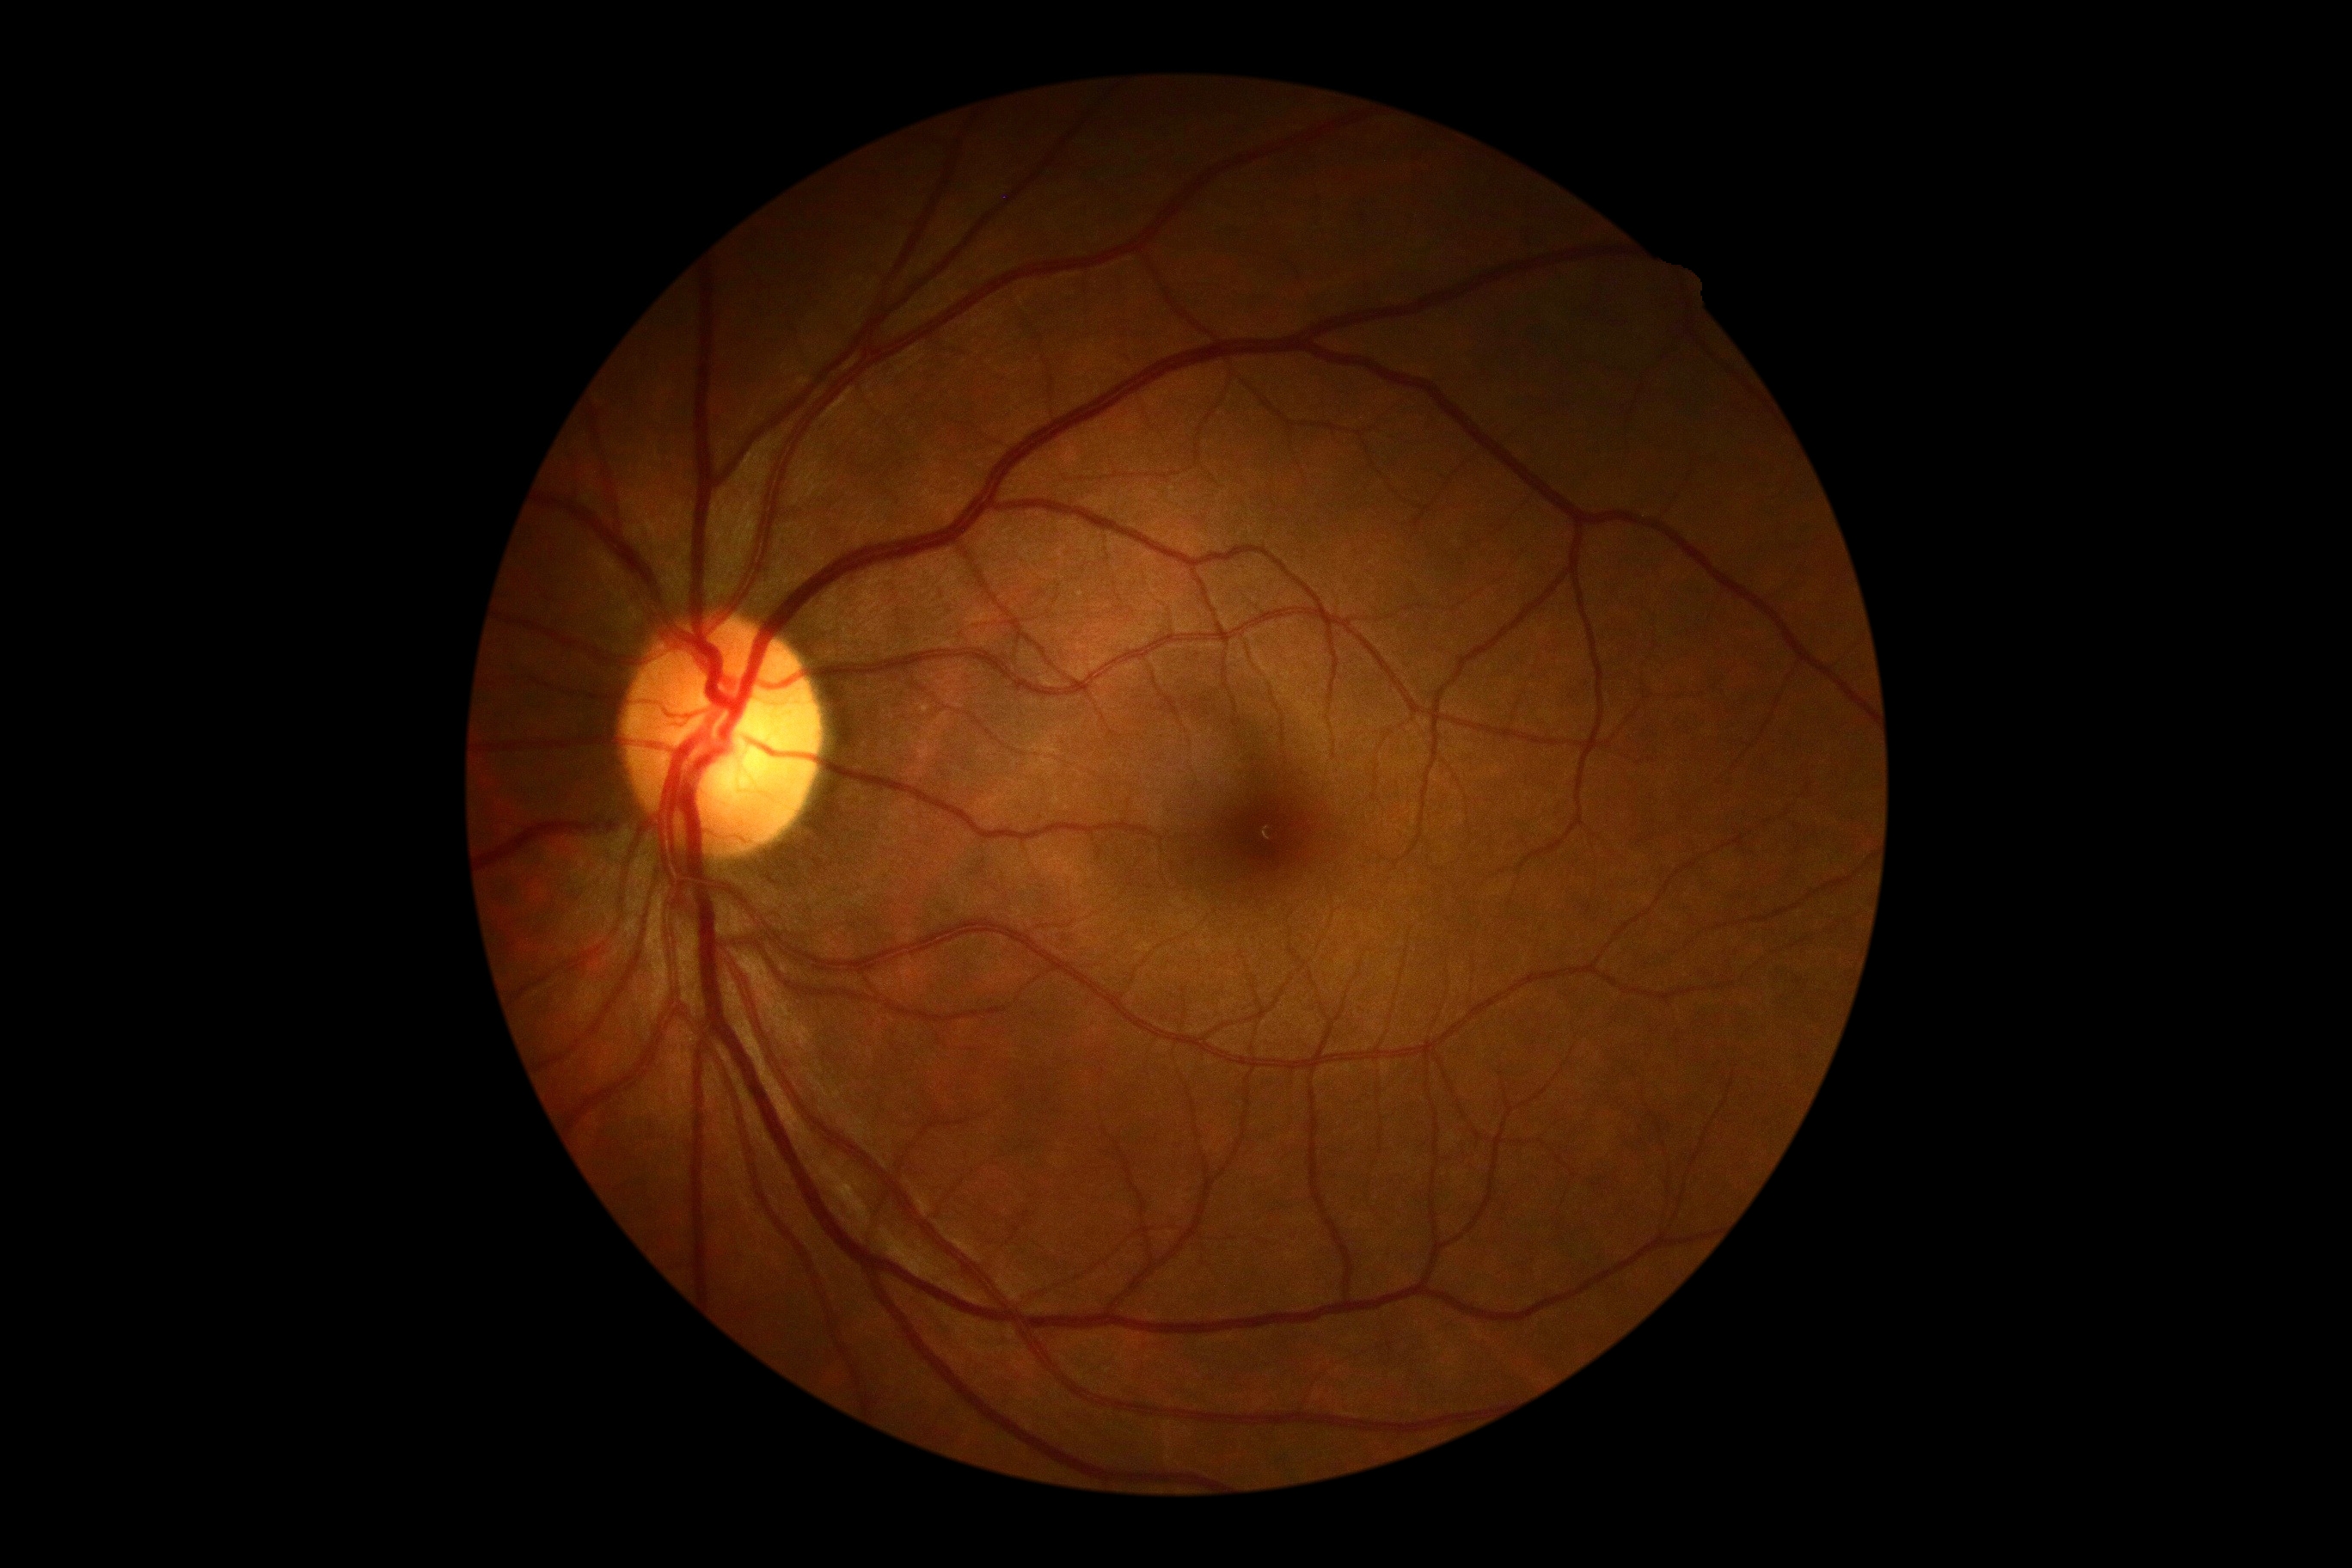

No diabetic retinal disease findings. Diabetic retinopathy (DR) is no apparent retinopathy (grade 0).